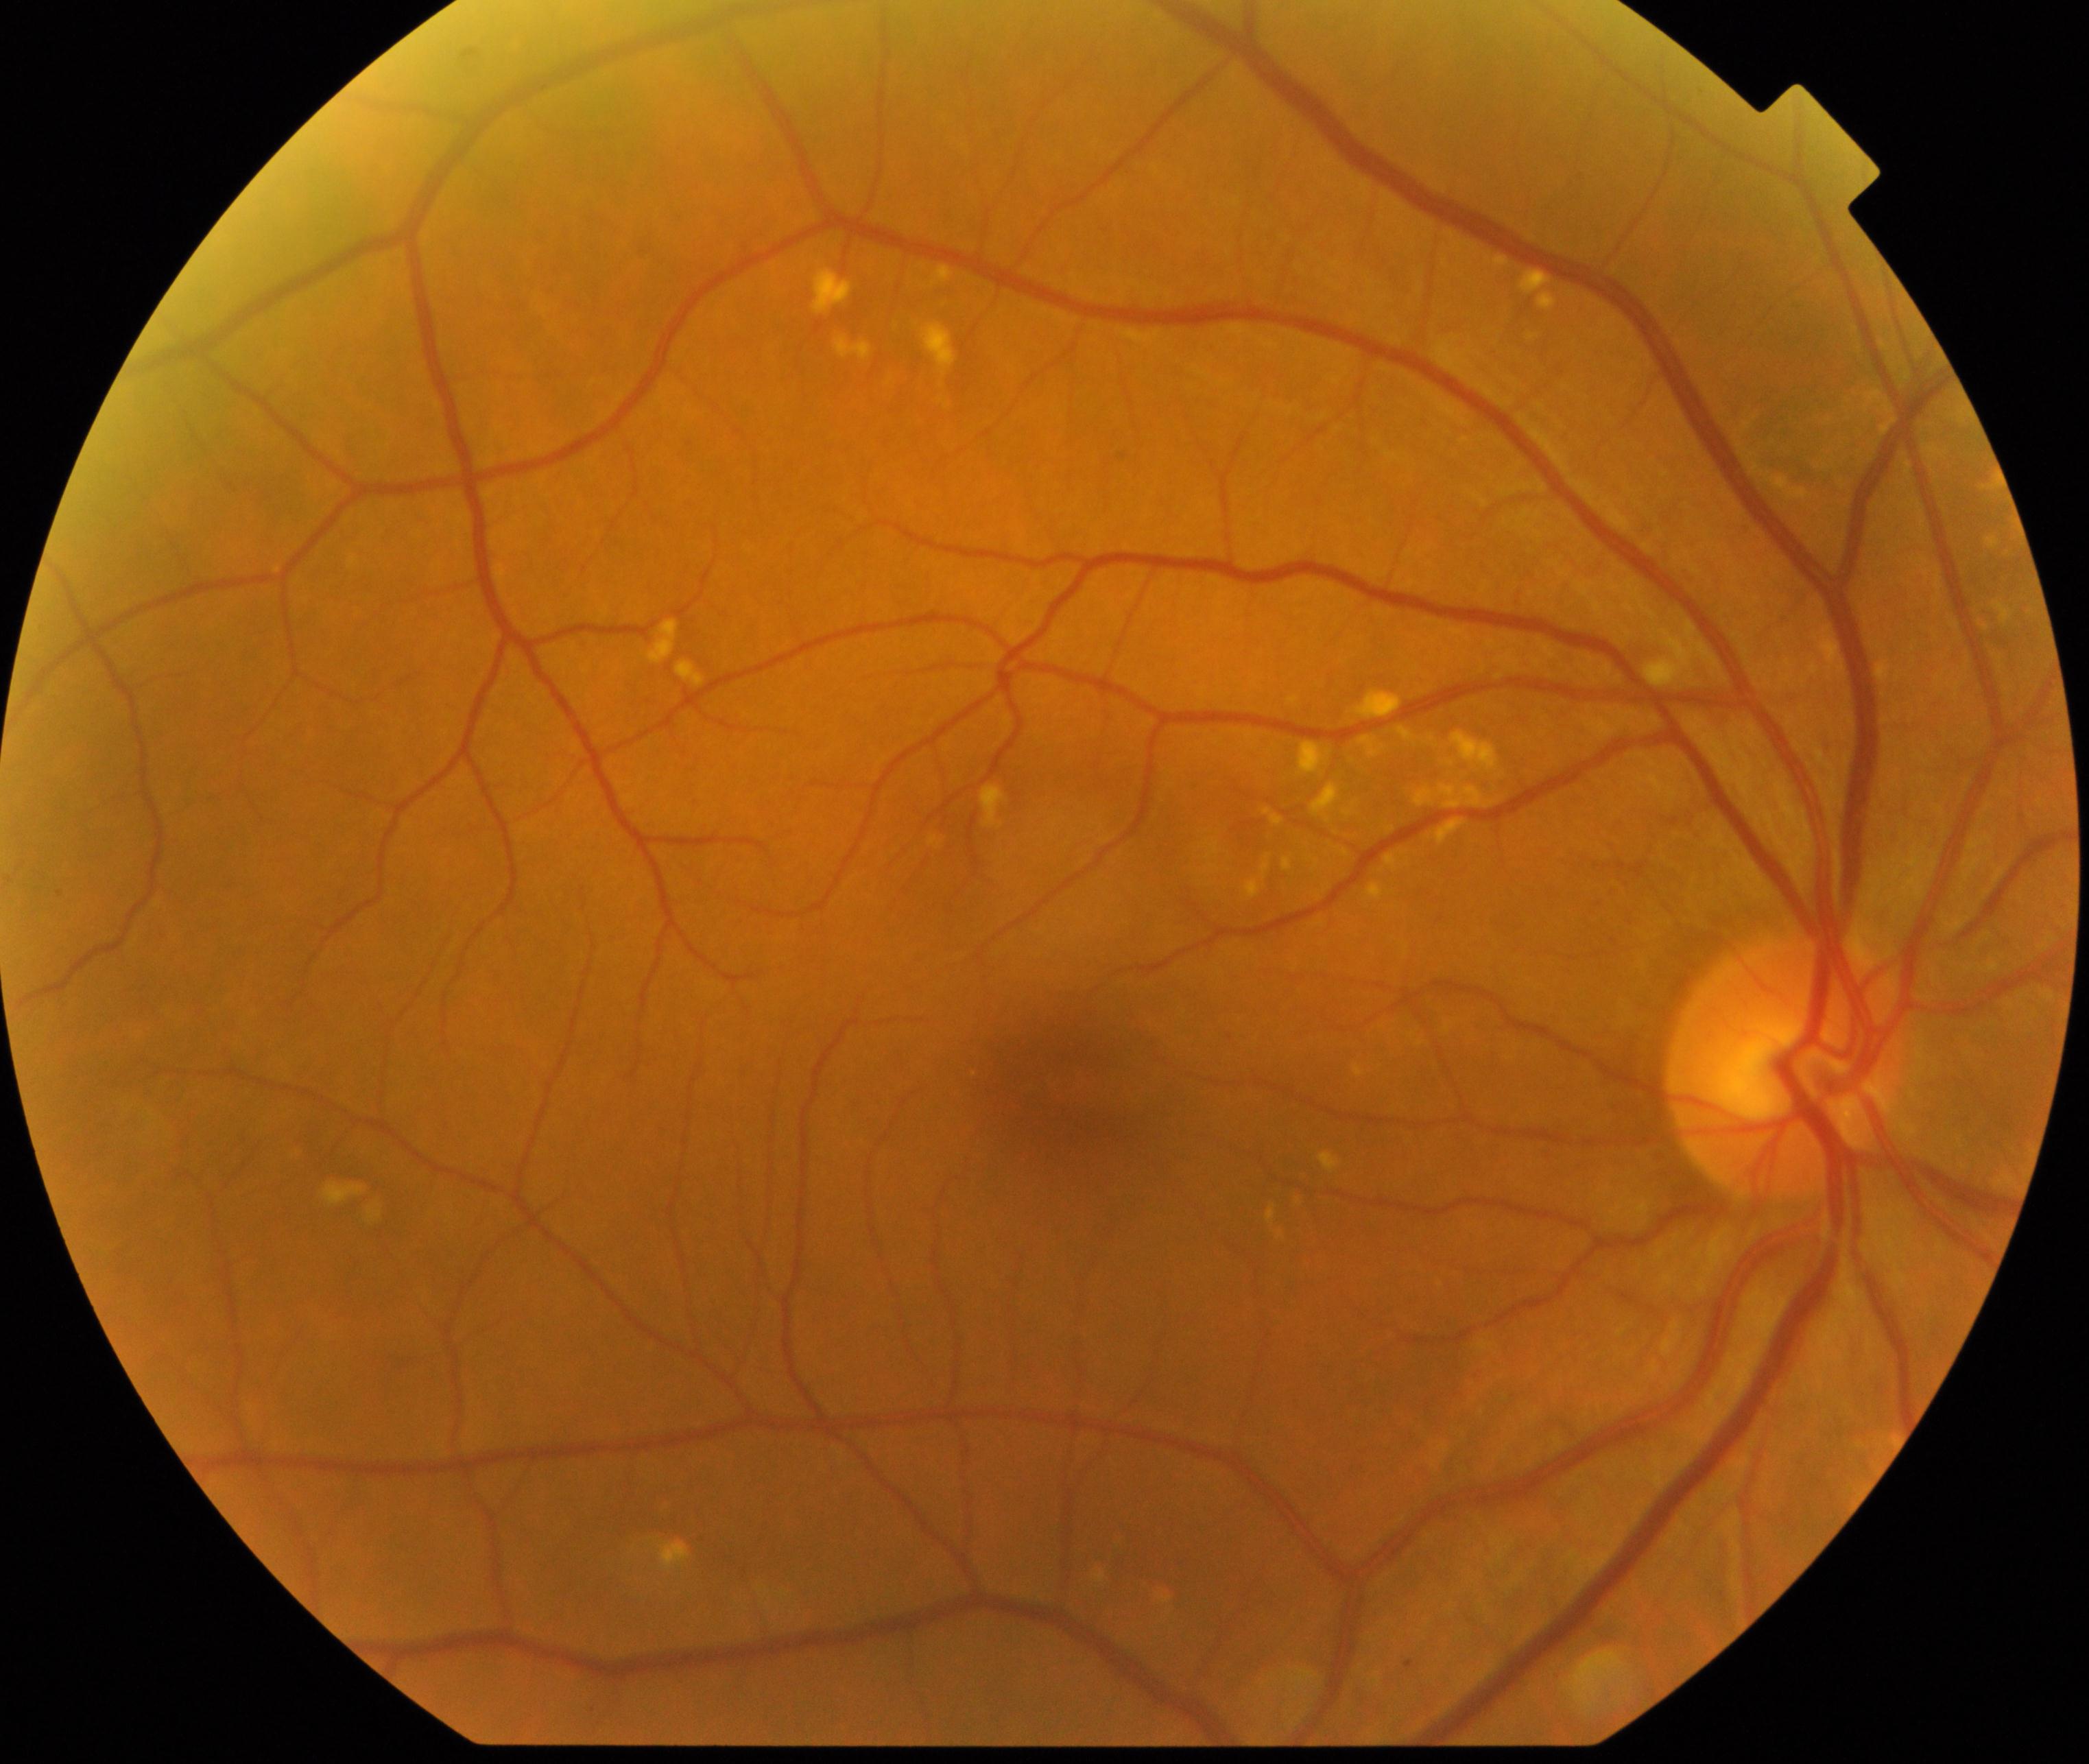

Findings: yellow-white spots or flecks.